45° FOV, color fundus image, 2352 x 1568 pixels — 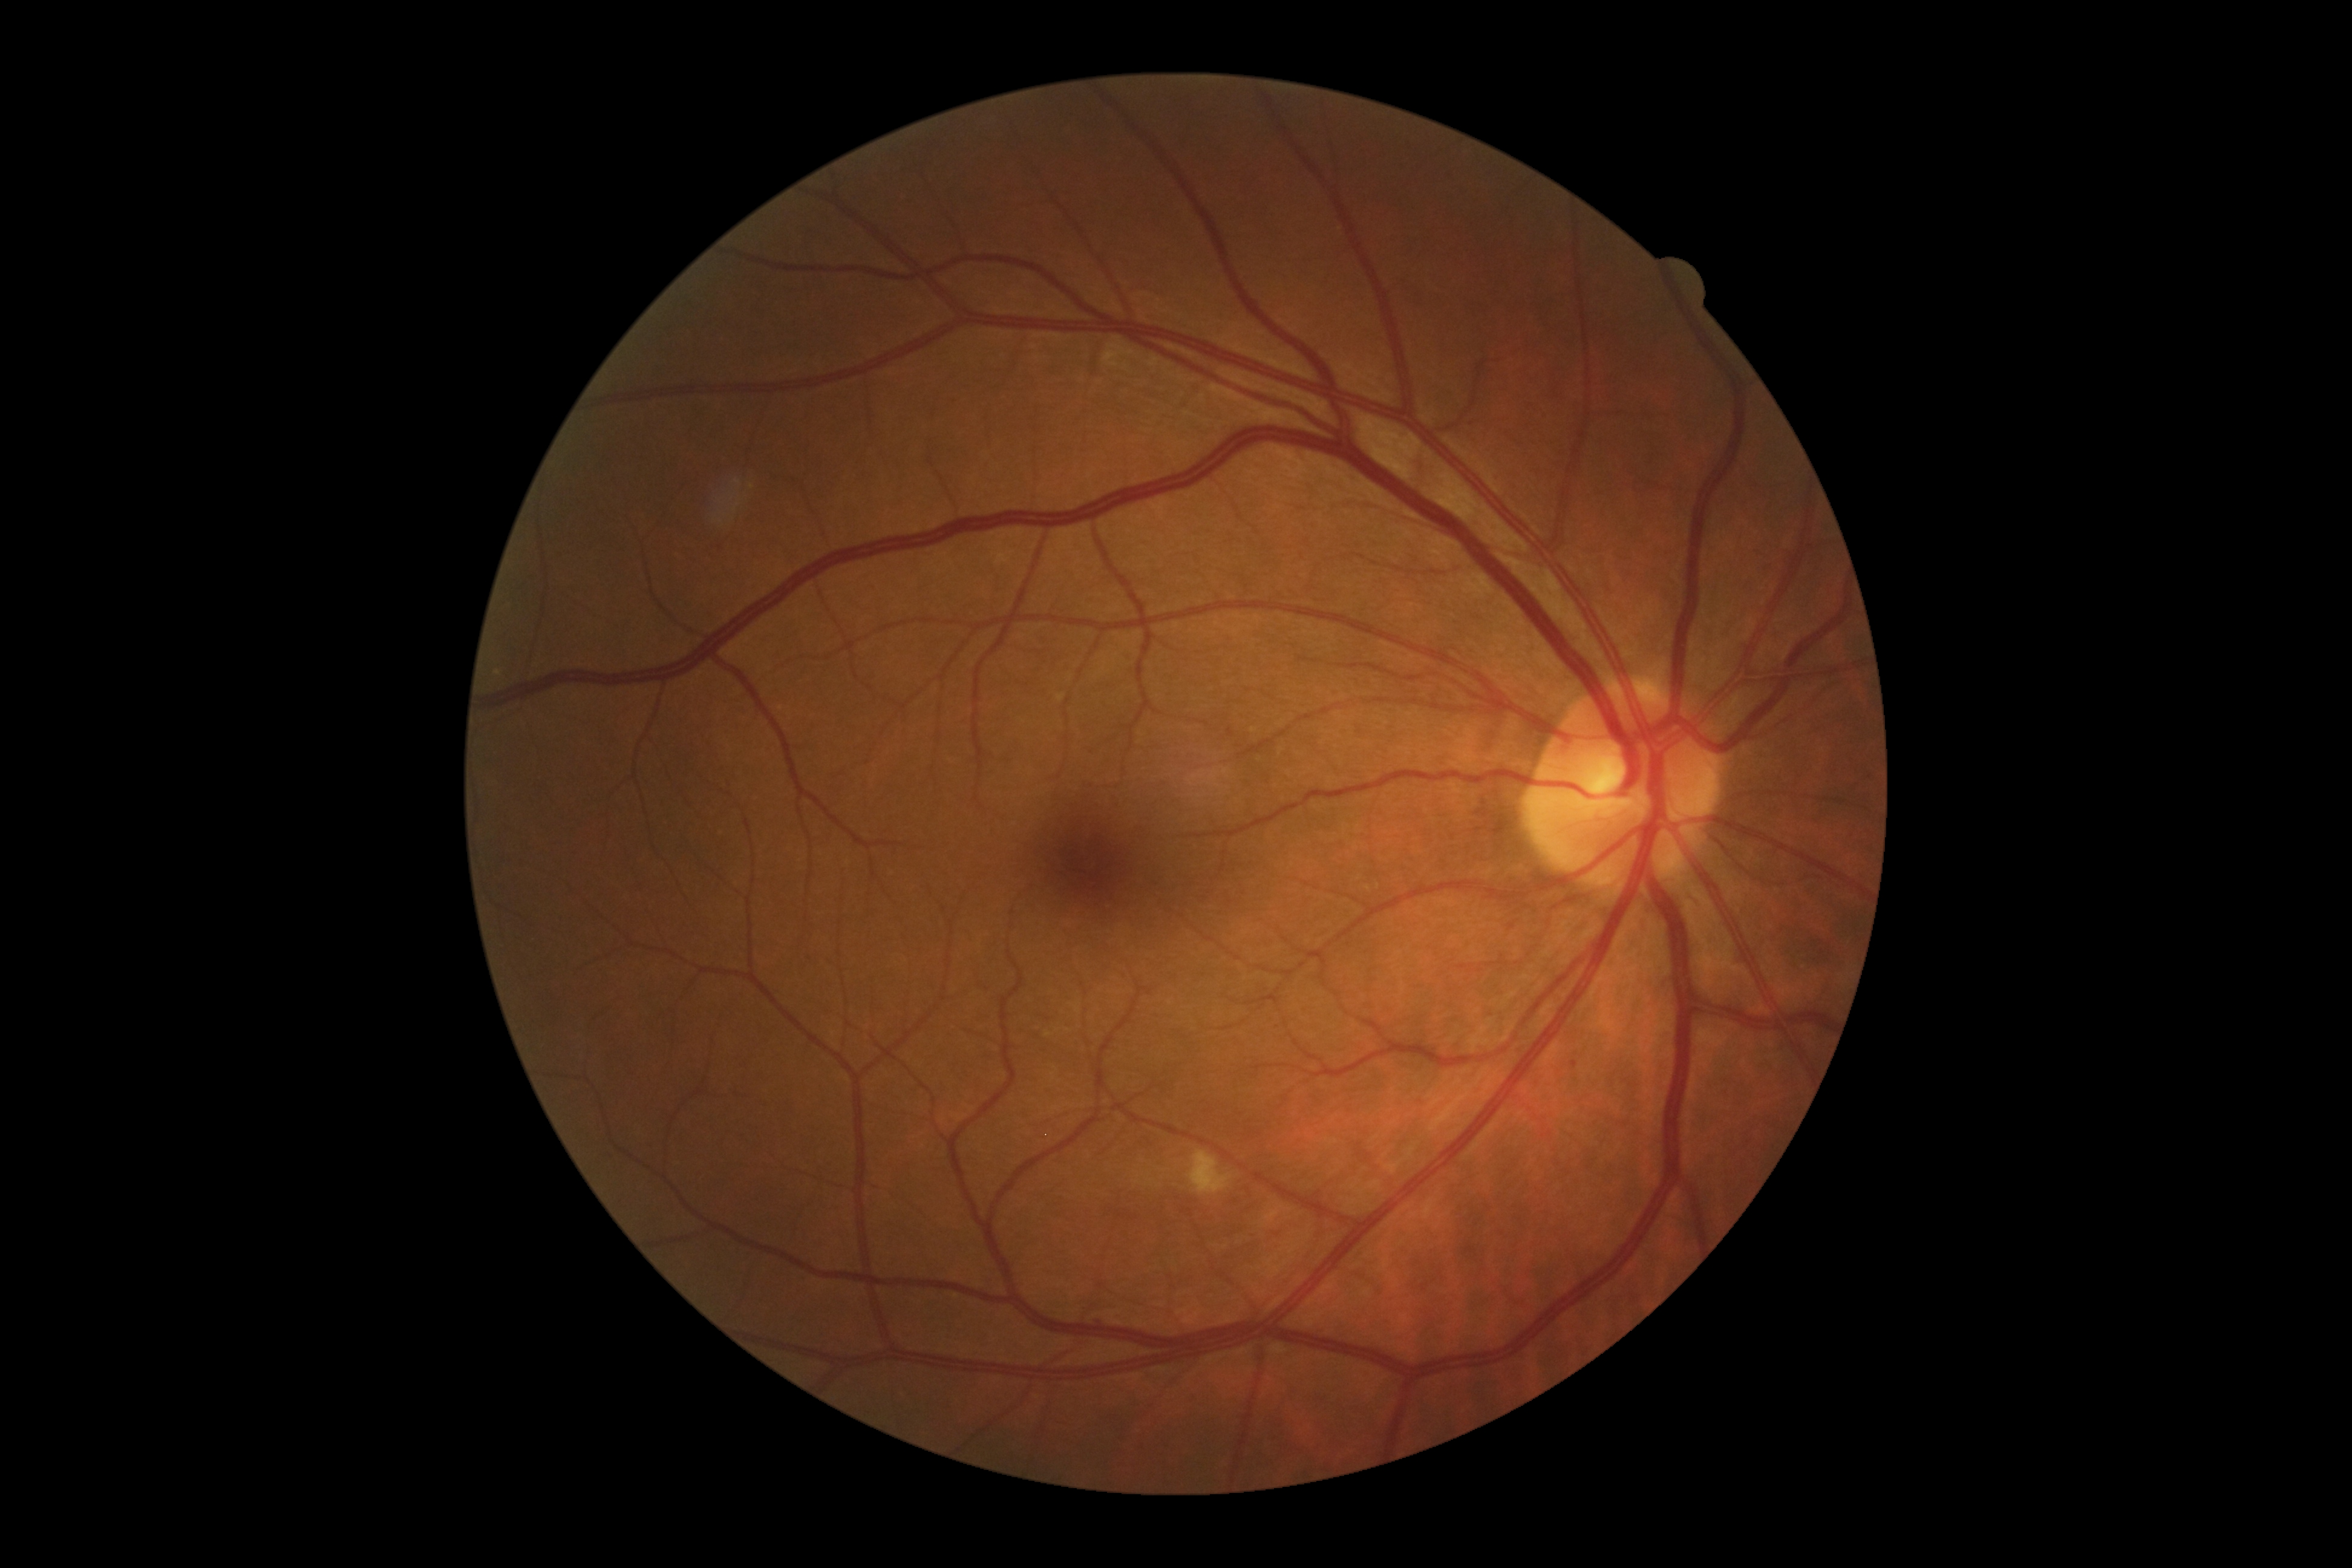 Diabetic retinopathy severity: grade 2 (moderate NPDR).